45 degree fundus photograph.
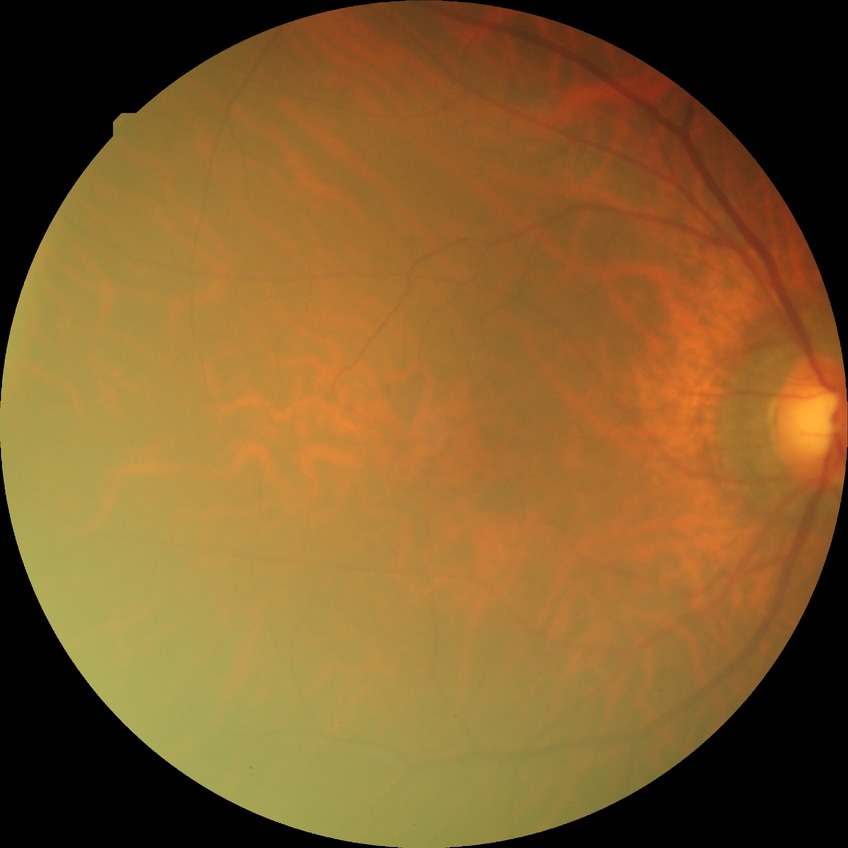 Diabetic retinopathy severity: no diabetic retinopathy.